Davis DR grading — 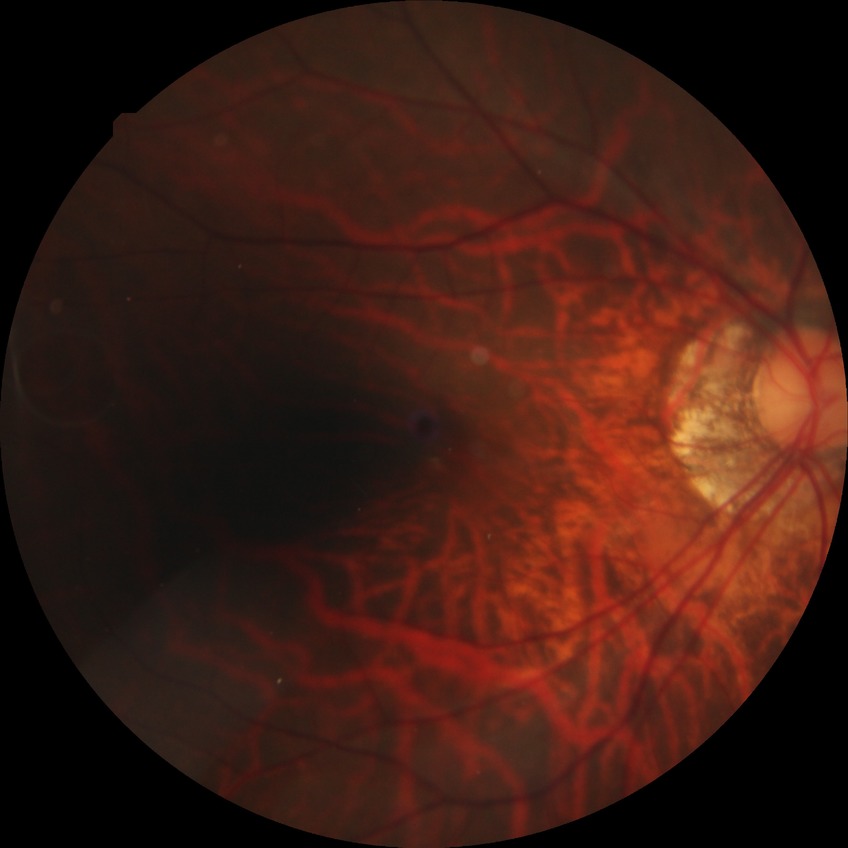
Assessment:
• diabetic retinopathy (DR): no diabetic retinopathy (NDR)